Wide-field fundus image from infant ROP screening; 1240x1240:
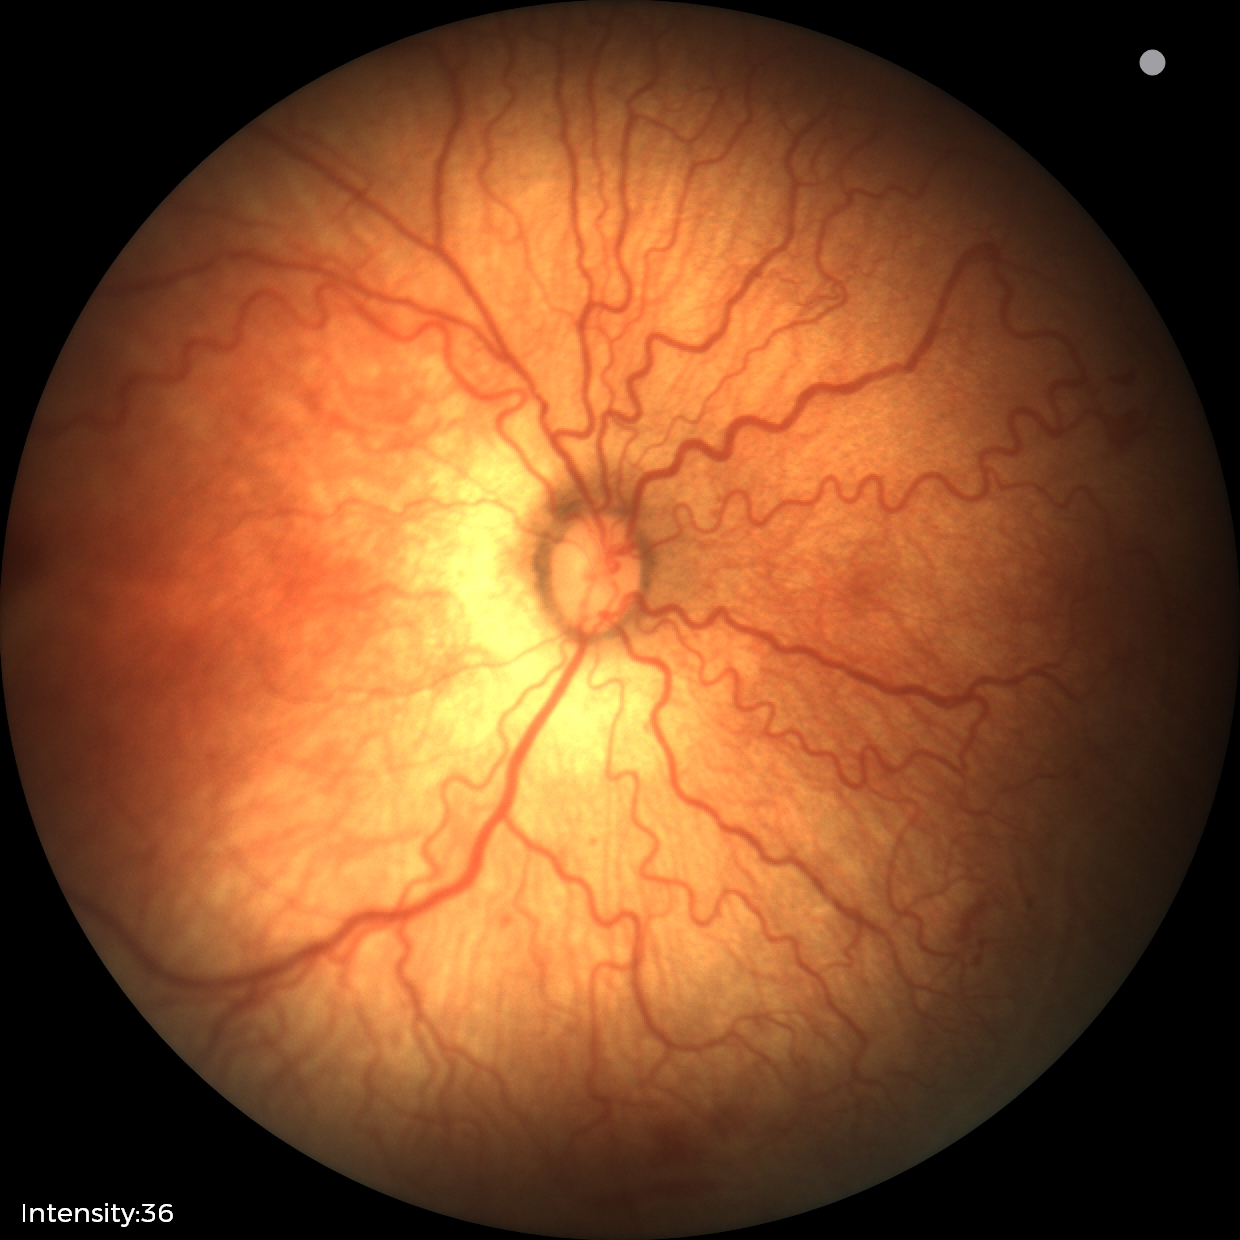 Impression: ROP stage 2.